848x848px. Davis DR grading:
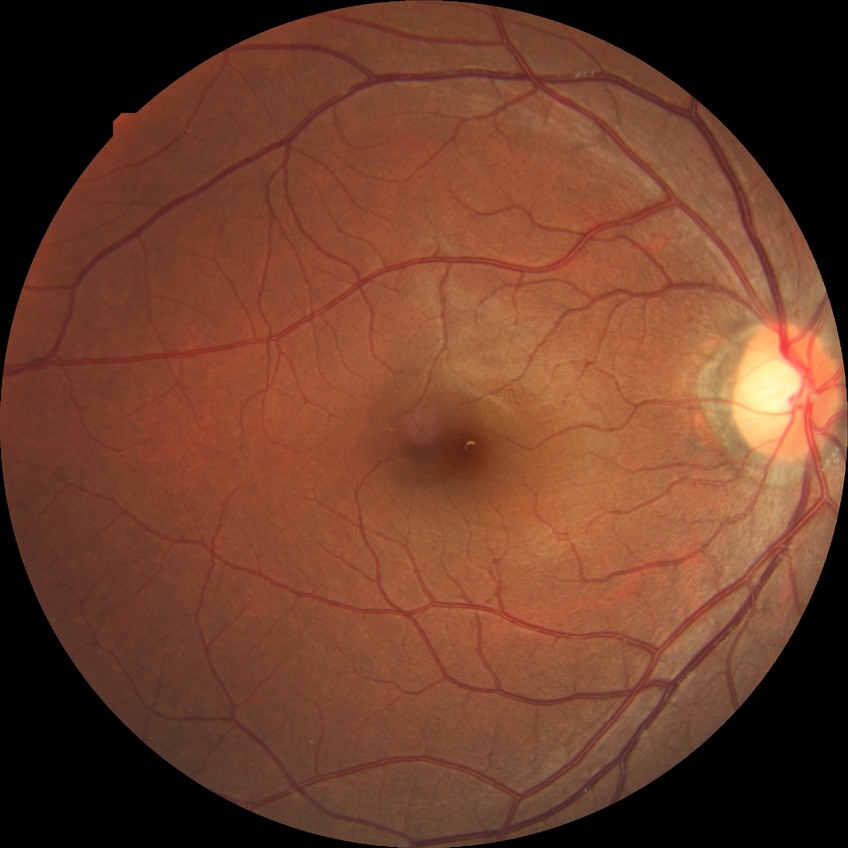 diabetic retinopathy (DR): NDR (no diabetic retinopathy).